2352x1568px; 45° field of view — 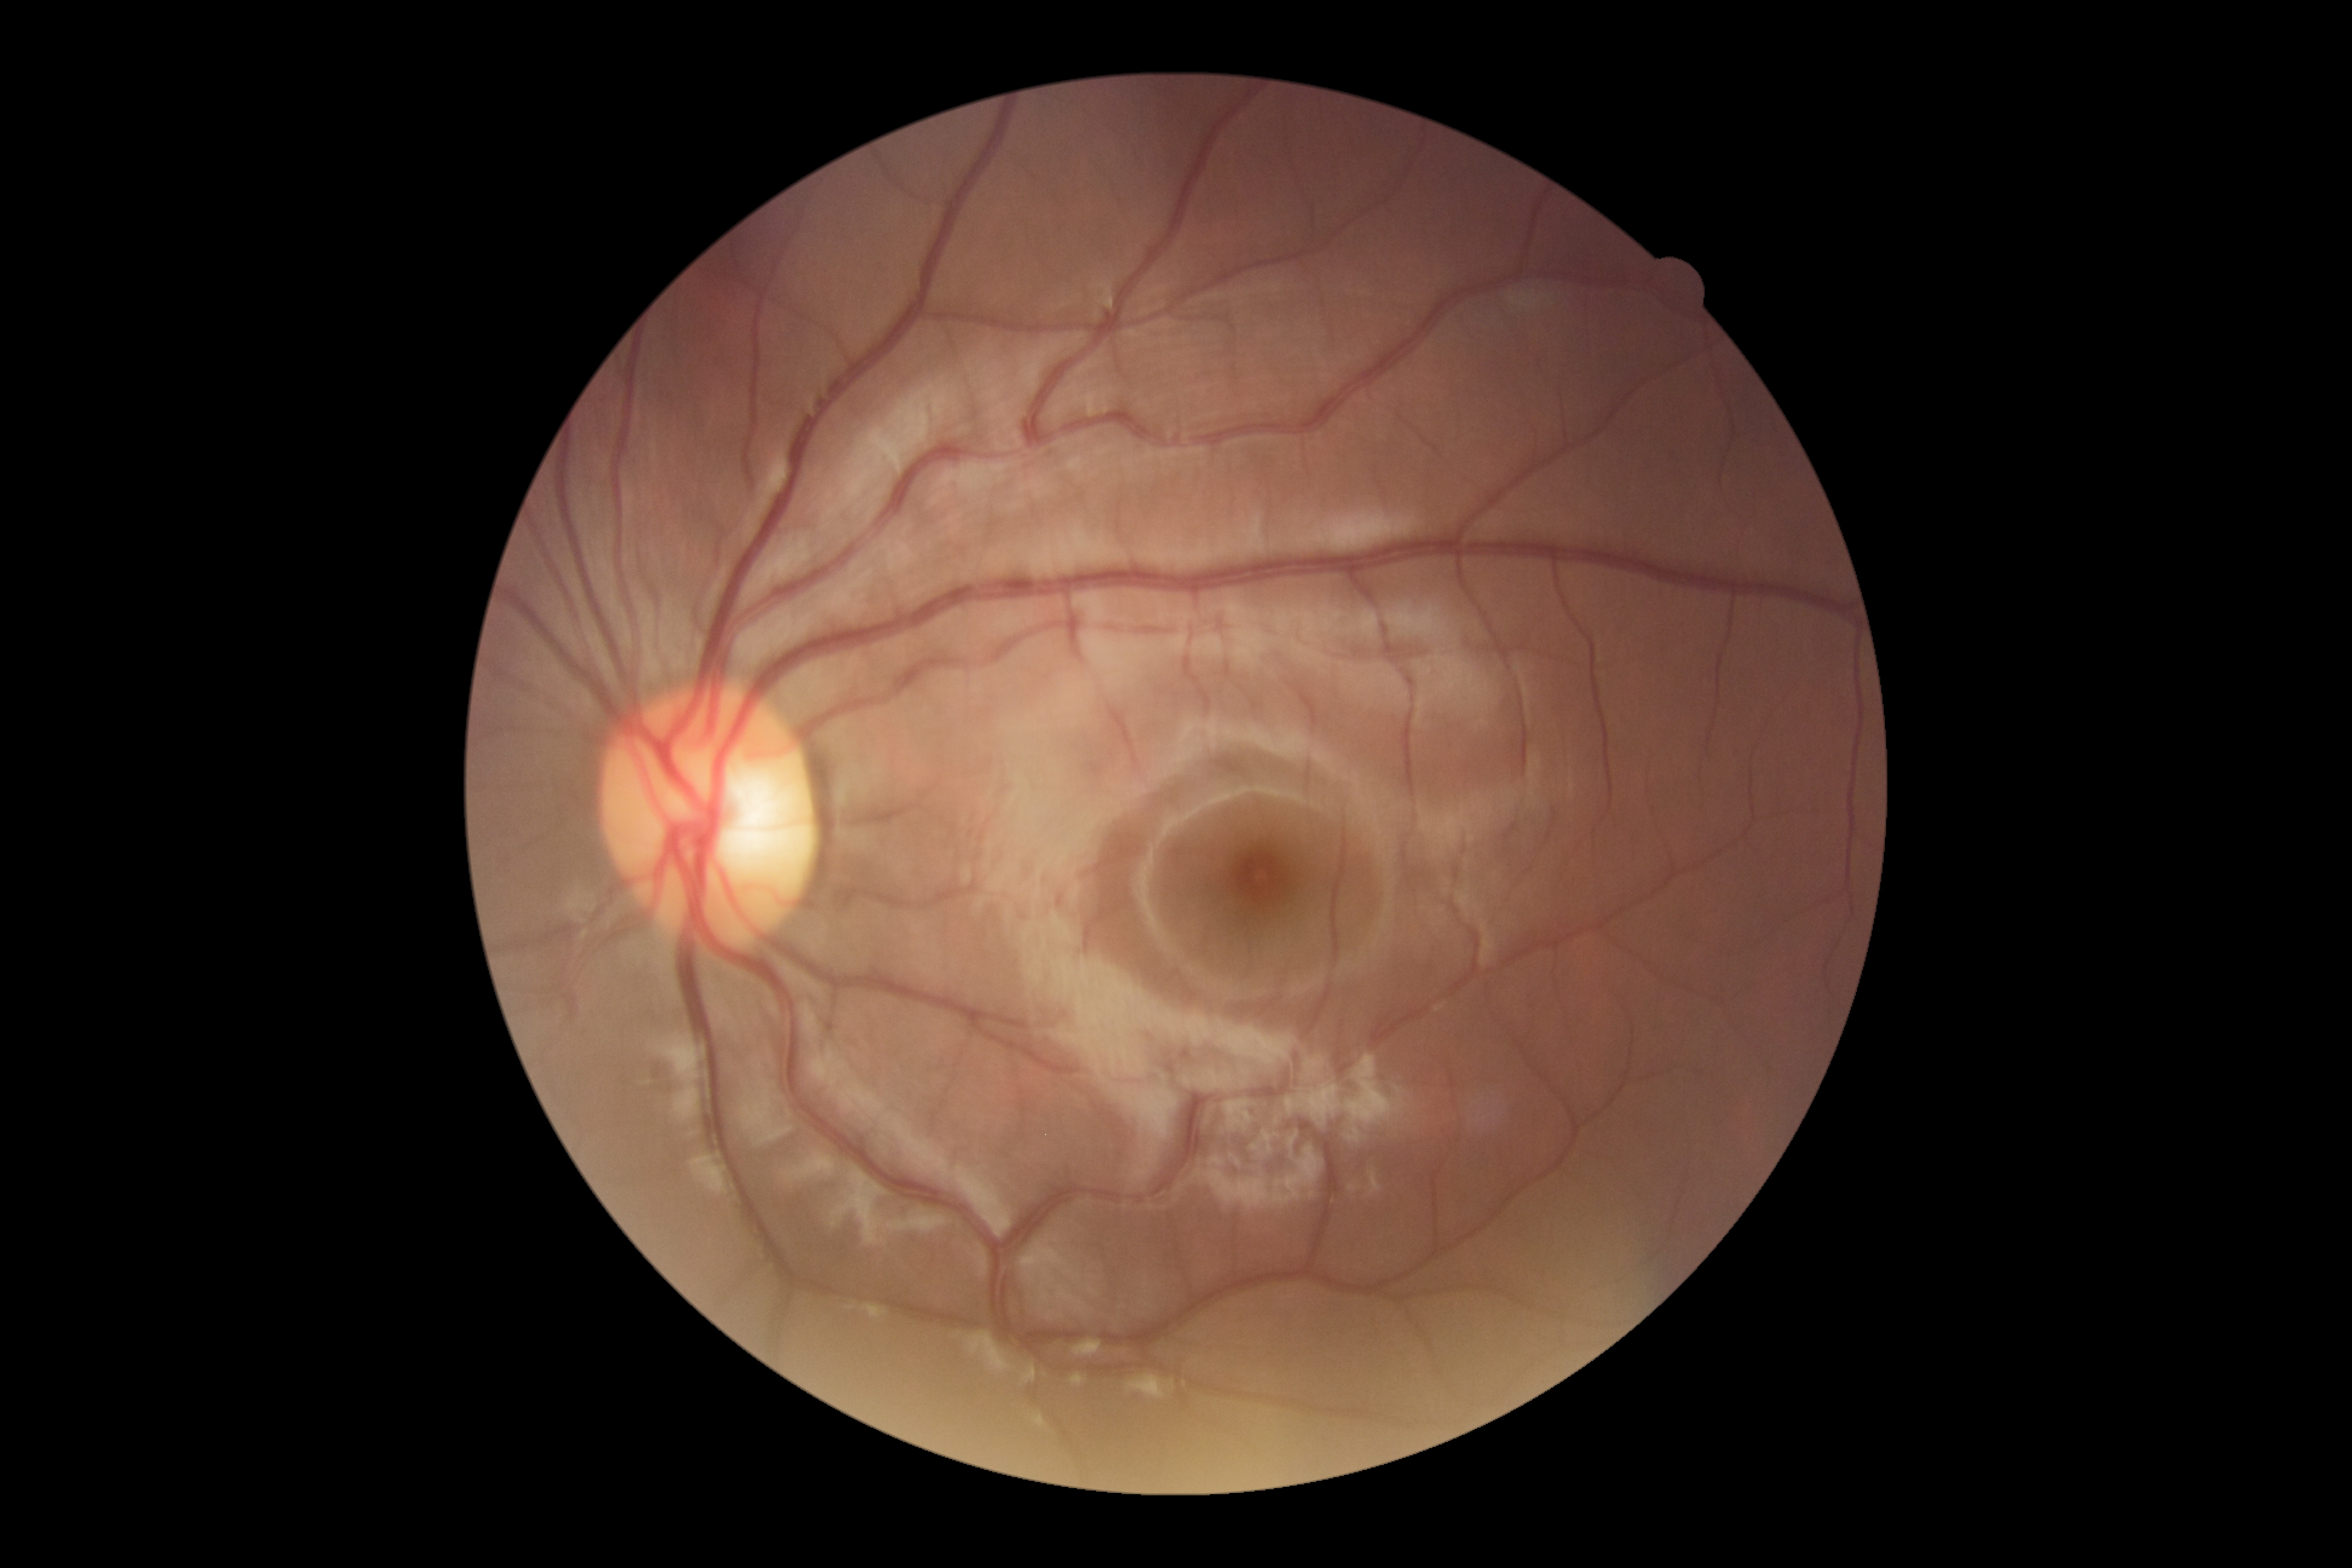
Diabetic retinopathy grade: 0.